DR severity per modified Davis staging — 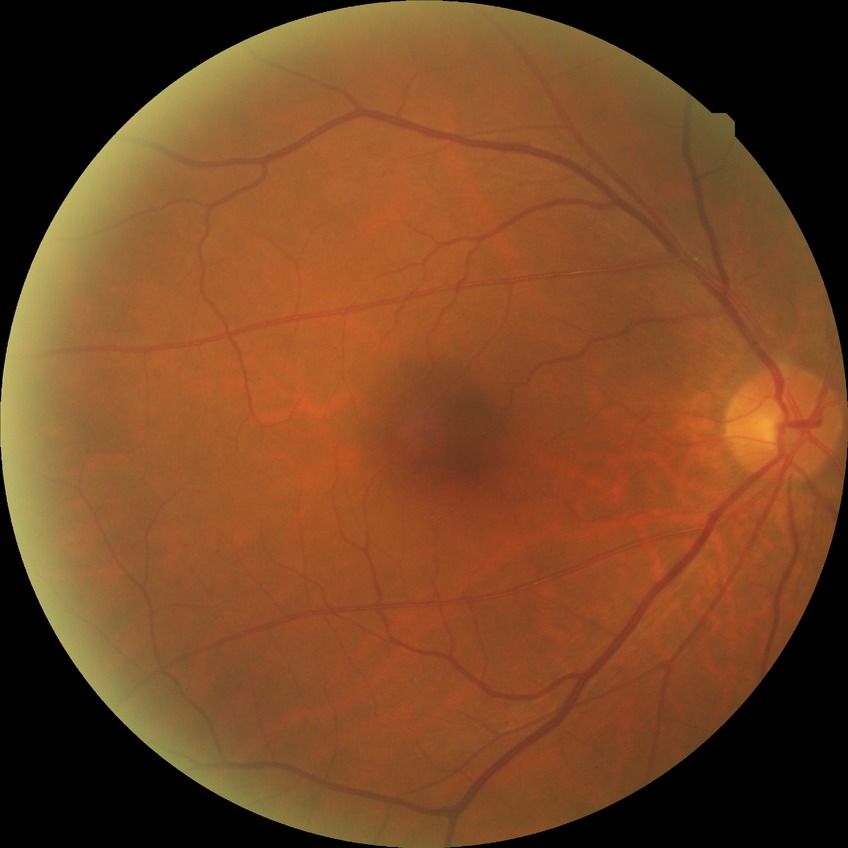
davis_grade: NDR (no diabetic retinopathy)